Modified Davis grading: 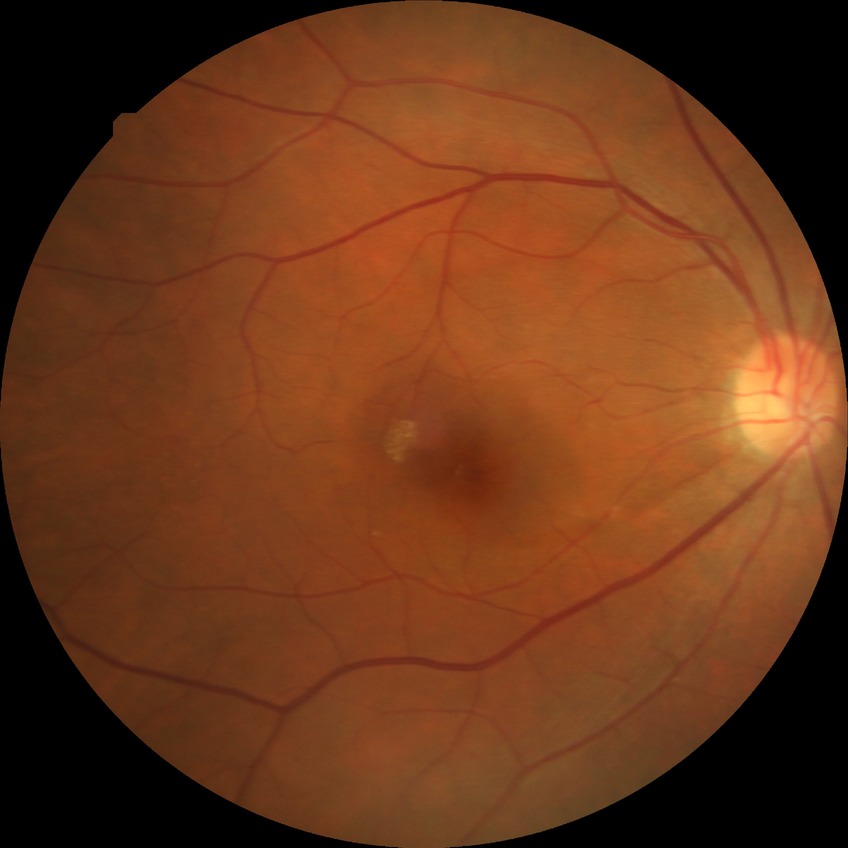
diabetic retinopathy (DR) = no diabetic retinopathy (NDR).